640x480; wide-field fundus image from infant ROP screening; Clarity RetCam 3, 130° FOV — 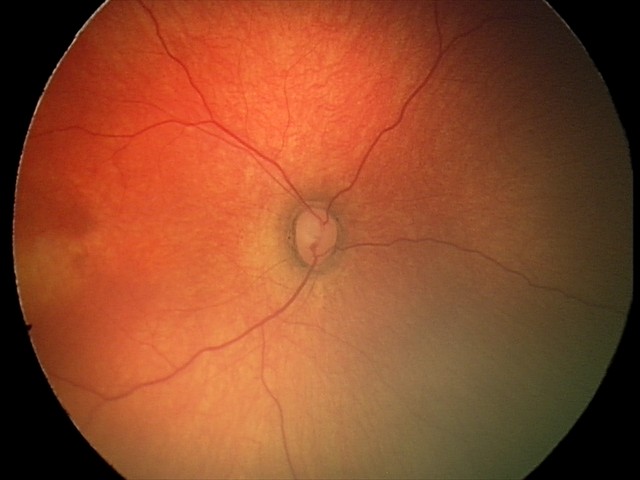
Assessment: no abnormal retinal findings.